CFP, 45° FOV:
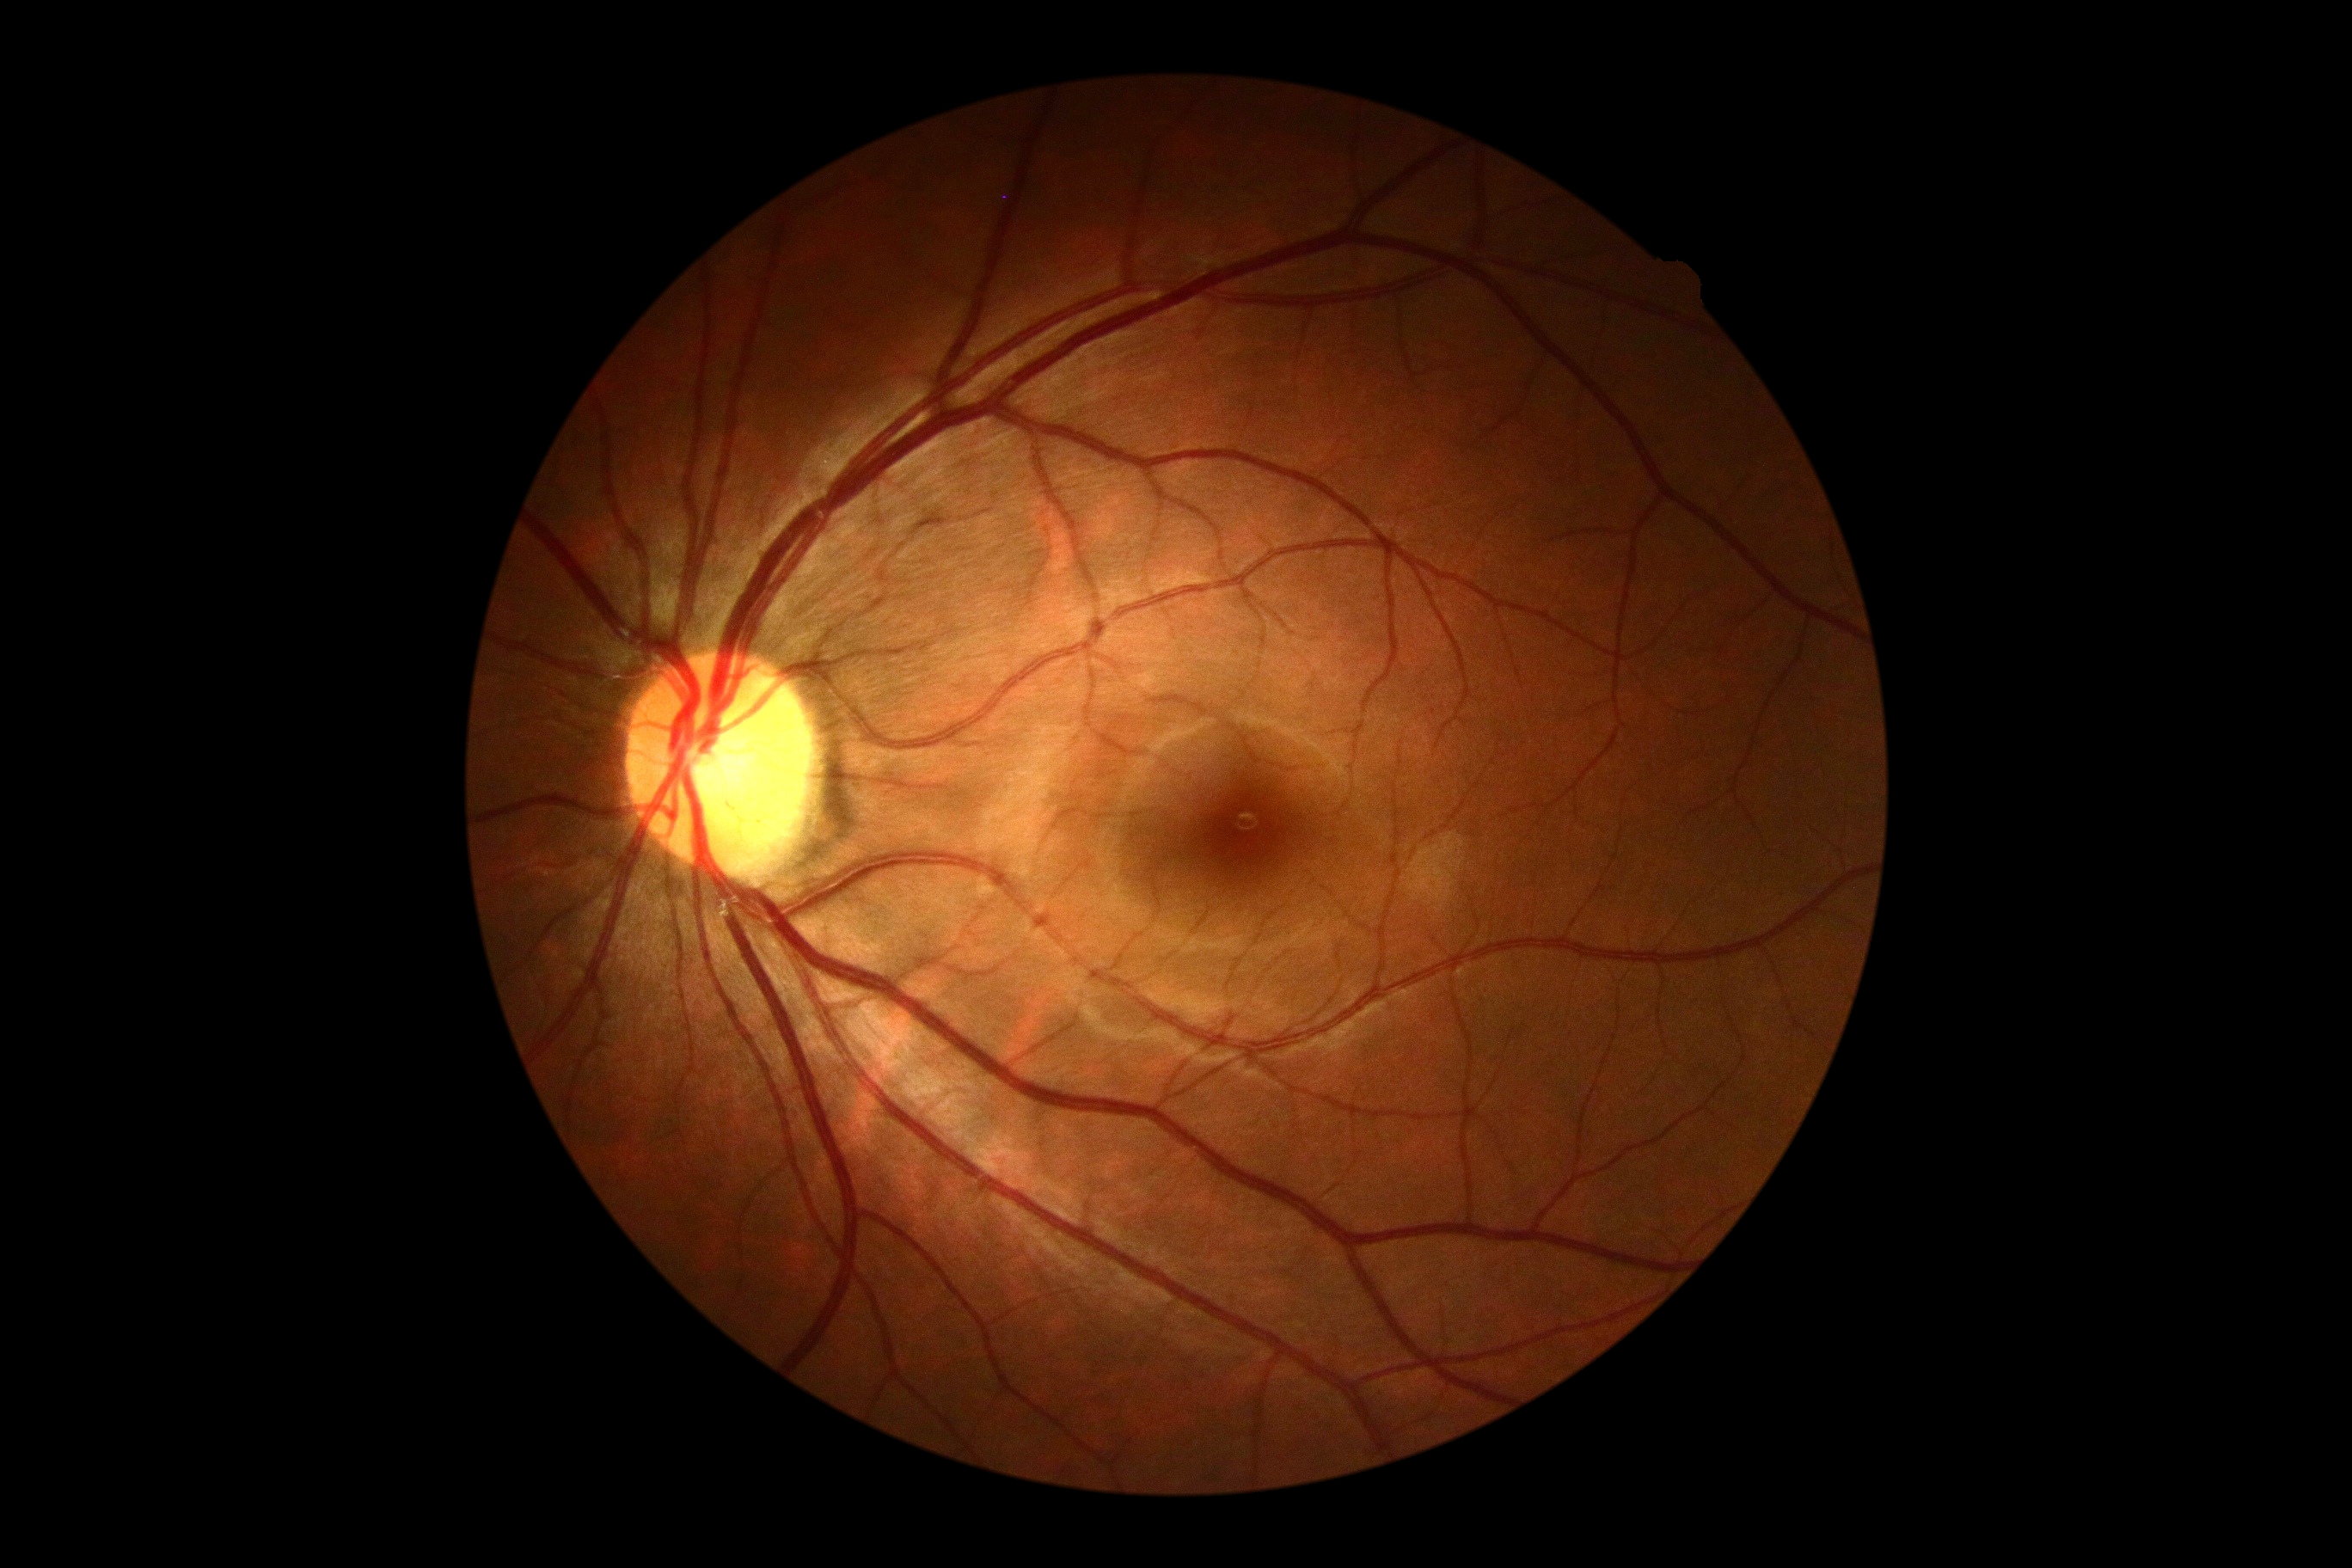
DR impression = no apparent DR
DR = grade 0 (no apparent retinopathy)